Nonmydriatic fundus photograph · fundus photo · acquired with a NIDEK AFC-230 · 848x848px
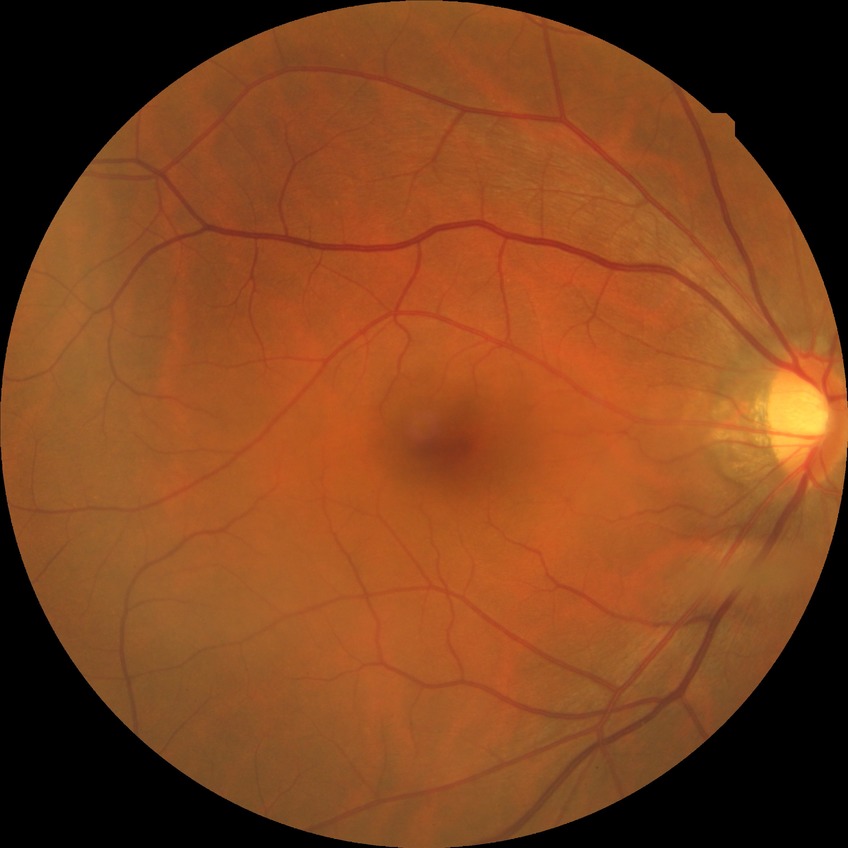 diabetic retinopathy severity: no diabetic retinopathy